1932 by 1932 pixels · color fundus image — 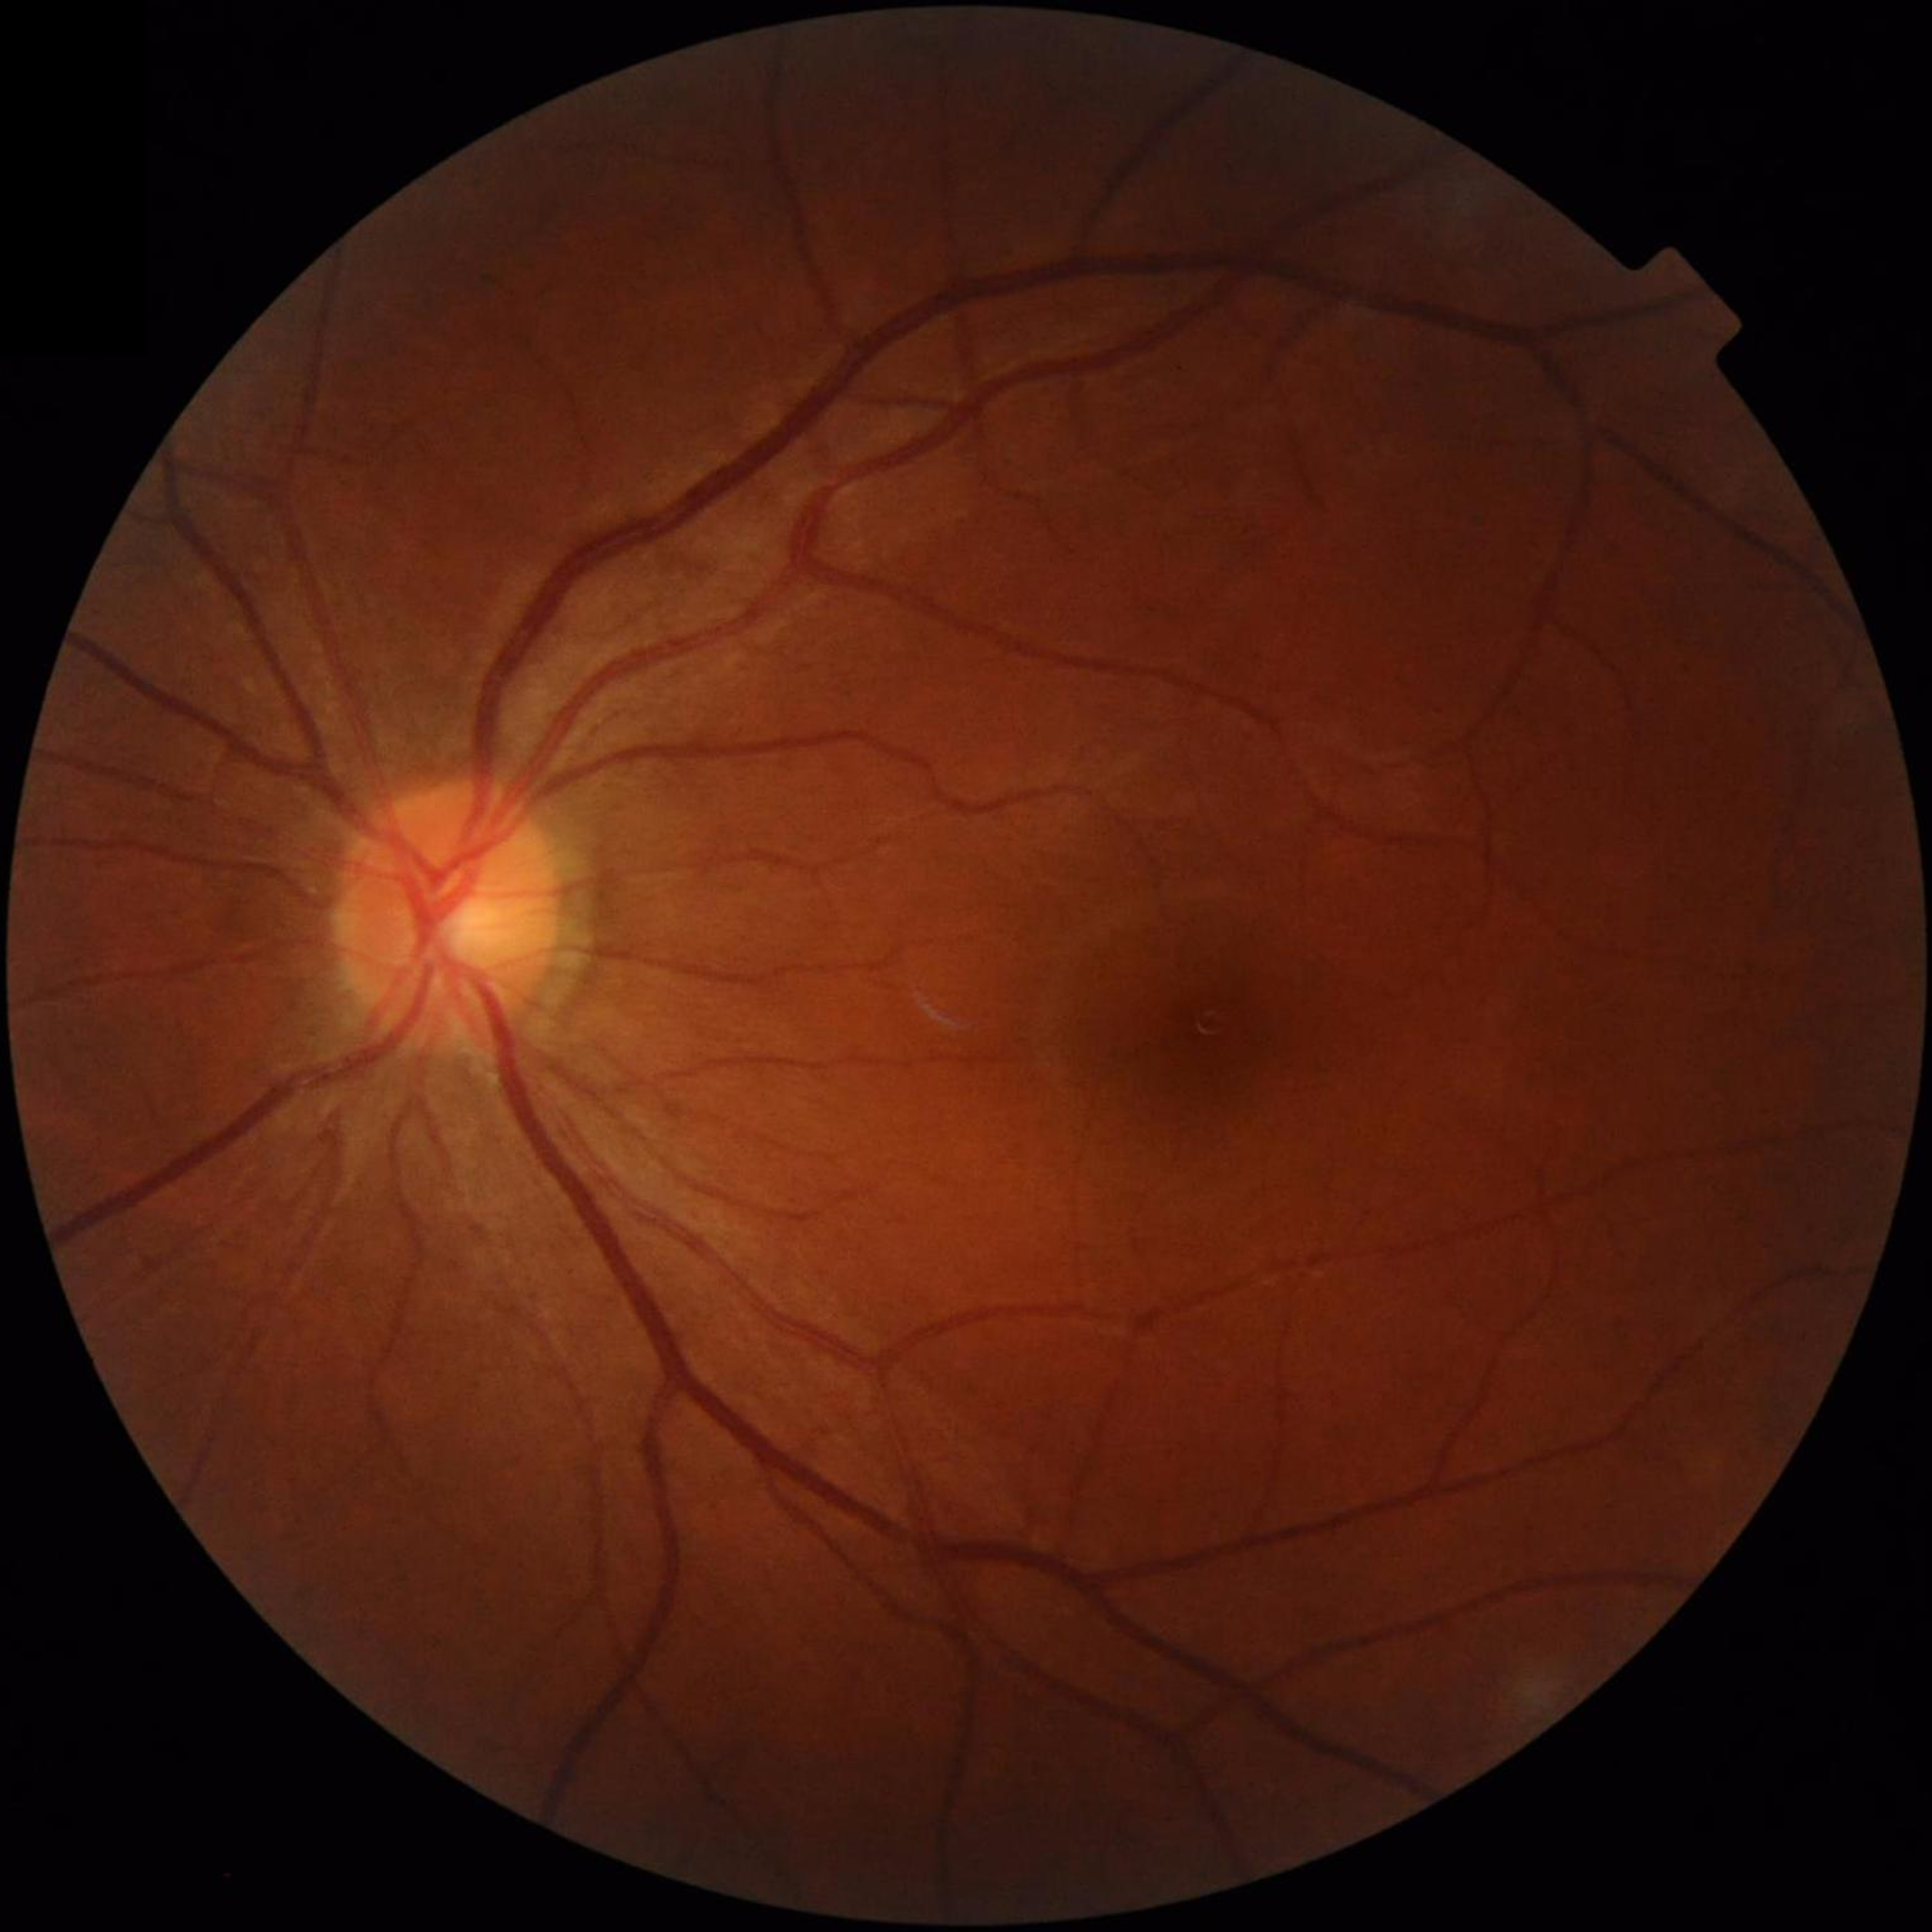

No AMD, DR, or glaucomatous findings.
Photo quality: no quality issues identified.